45-degree field of view; modified Davis grading: 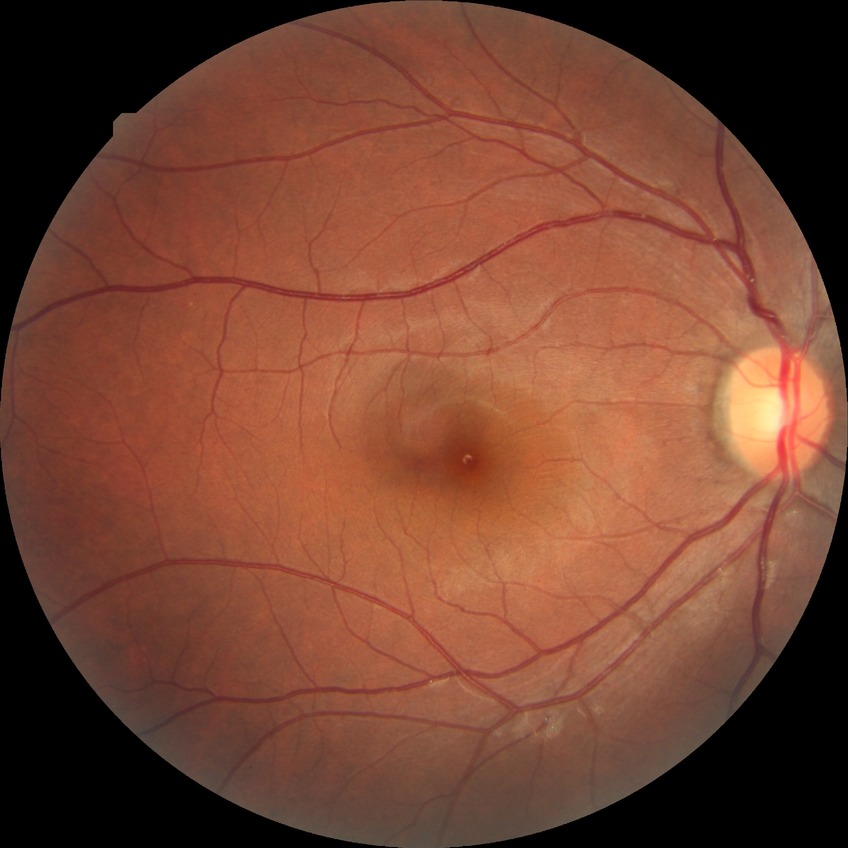
No apparent diabetic retinopathy. Davis grade: NDR.